Retinal fundus photograph; 45° FOV: 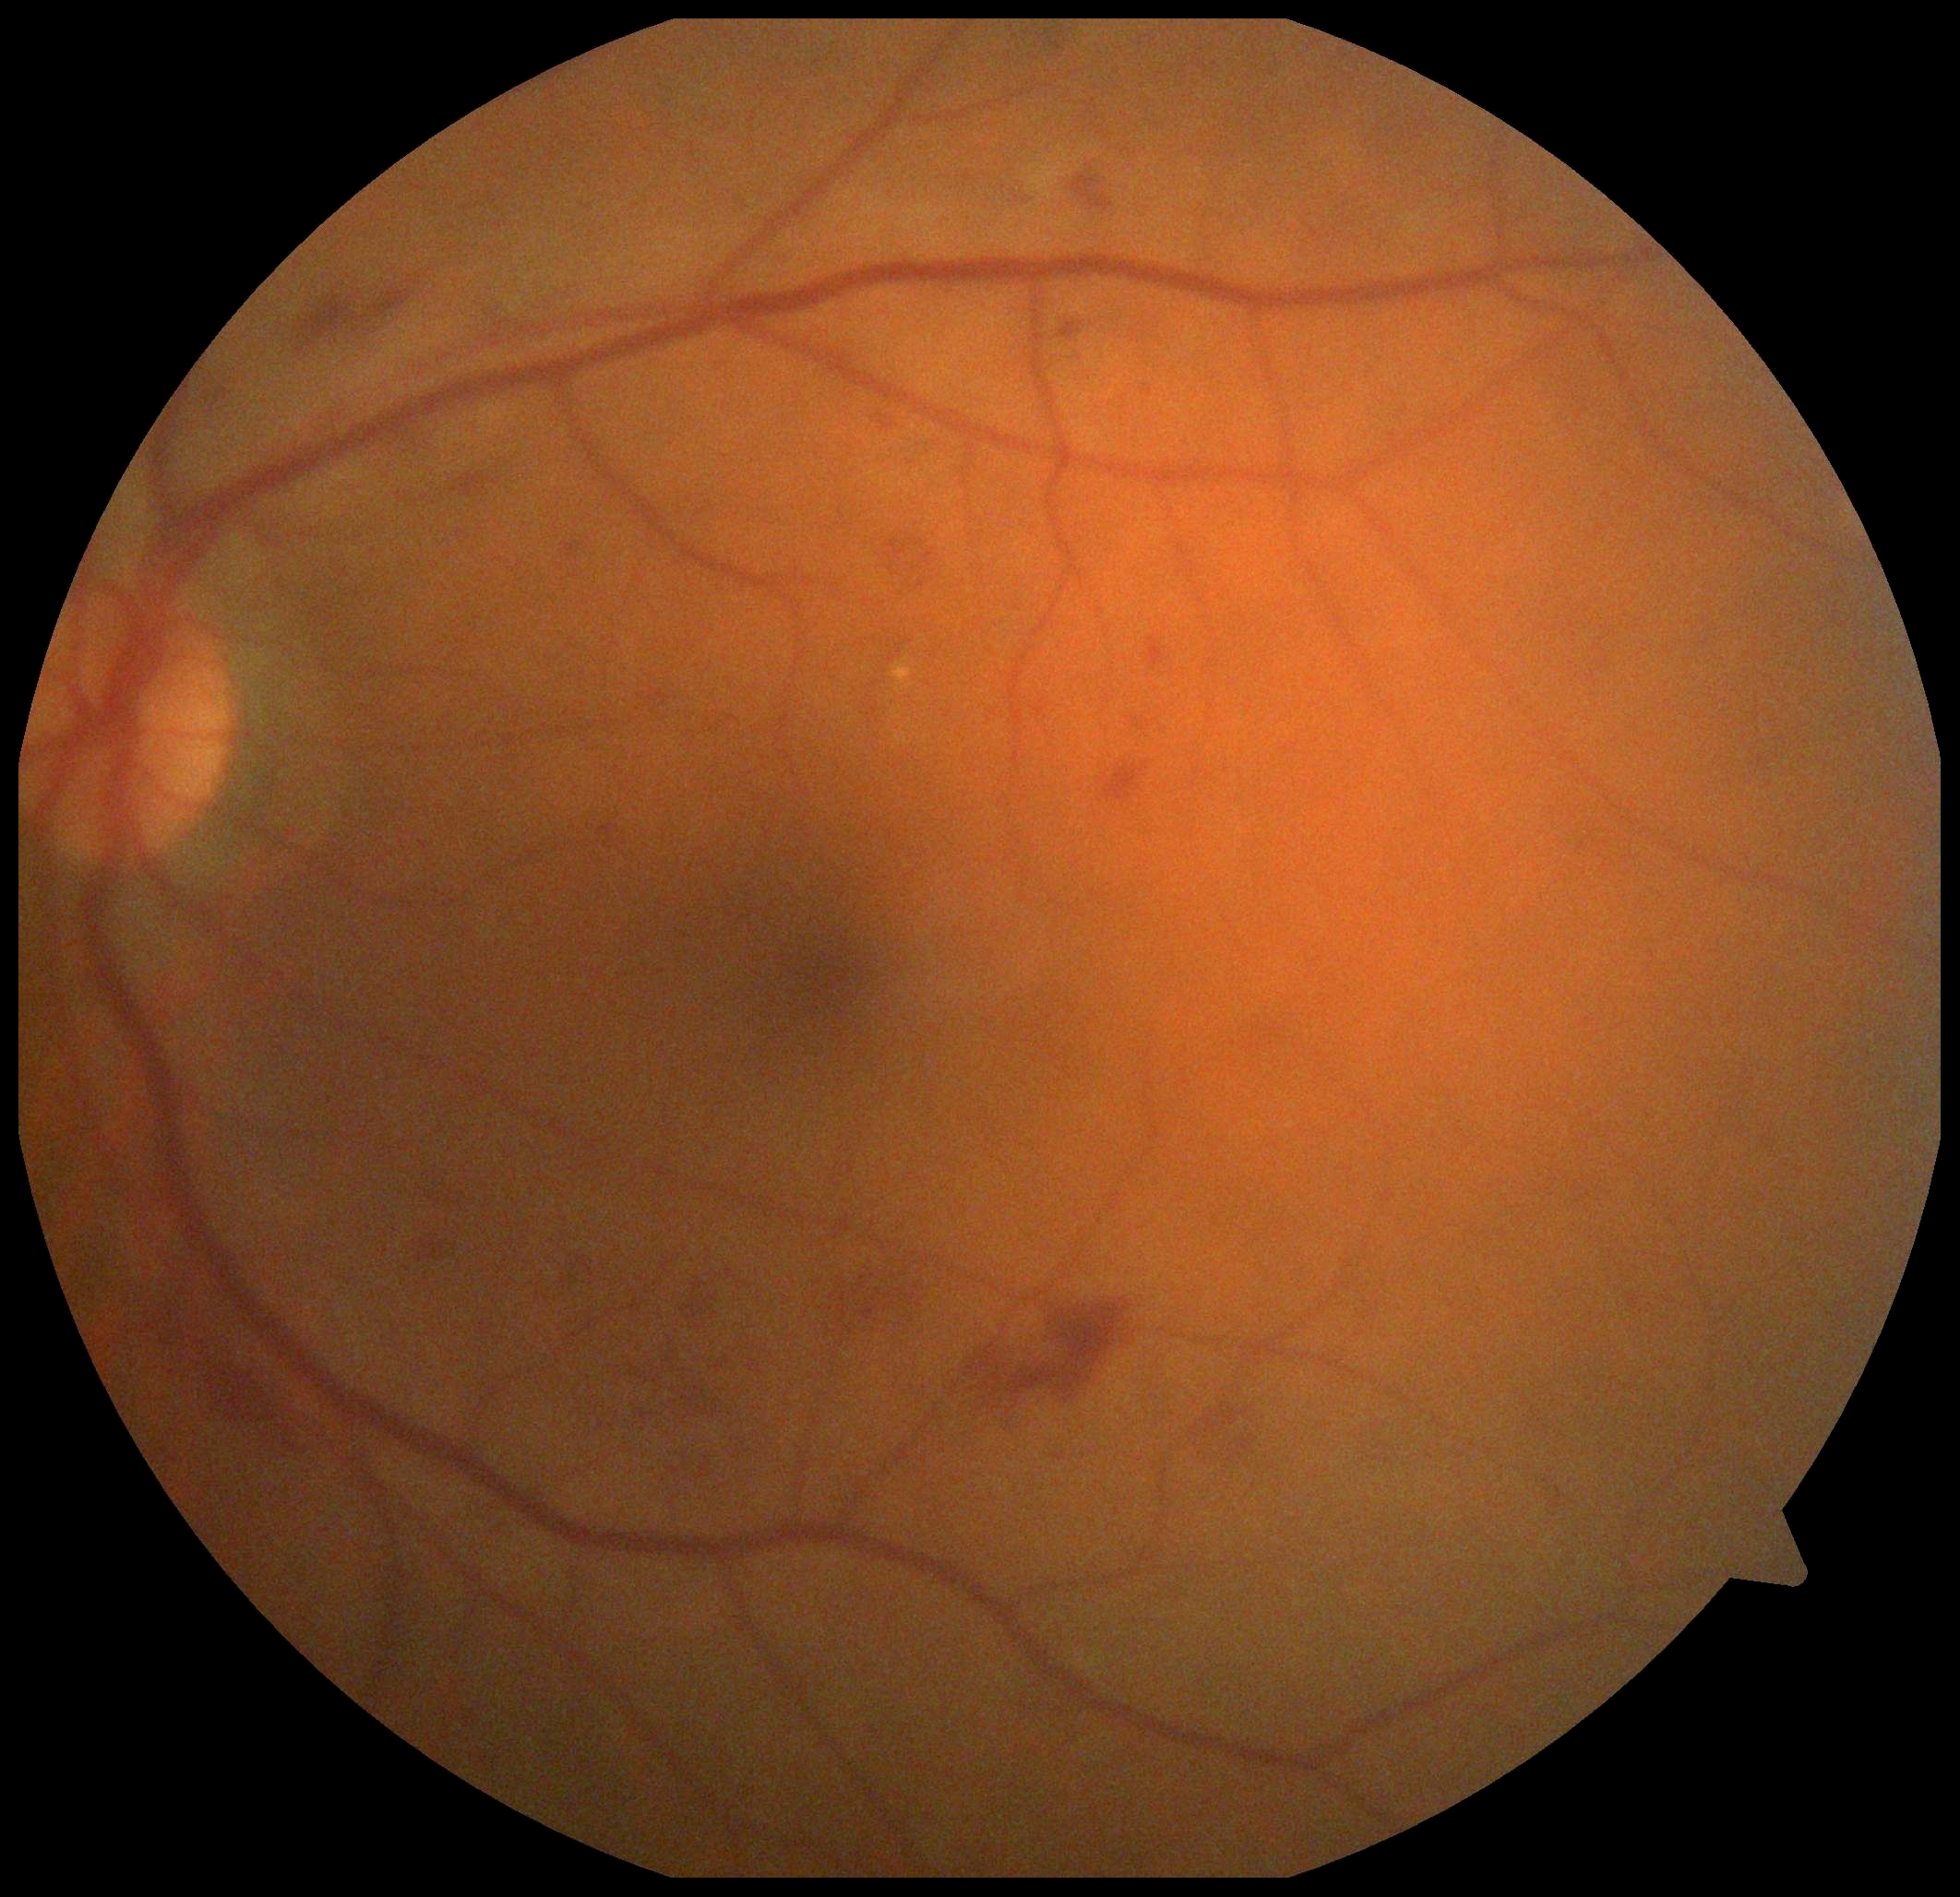

{
  "dr_category": "non-proliferative diabetic retinopathy",
  "dr_grade": "moderate NPDR (grade 2)"
}